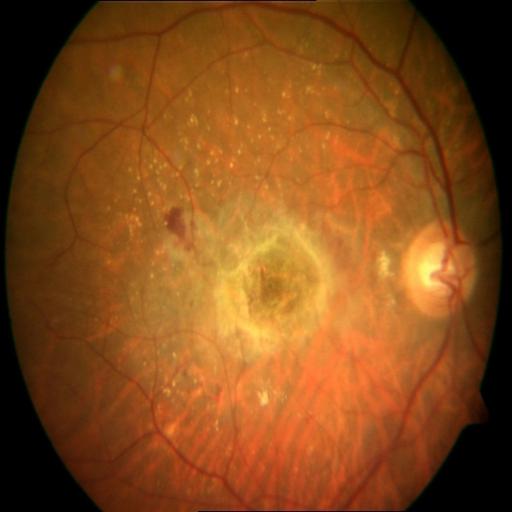

Pathology:
- age-related macular degeneration (ARMD)
- macular scar (MS)